240 by 240 pixels; acquired with a Nidek AFC-330; non-mydriatic acquisition:
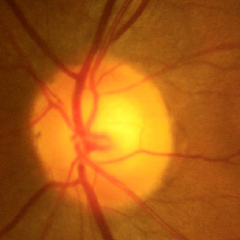
The image shows no glaucomatous changes.